DR severity per modified Davis staging:
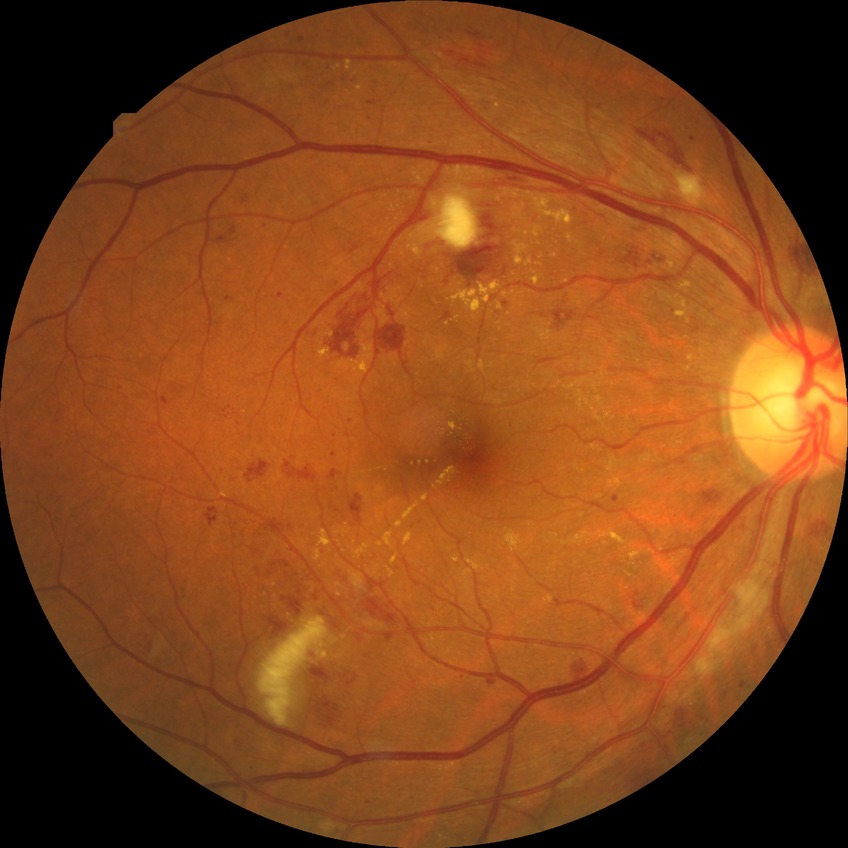
DR class: non-proliferative diabetic retinopathy, diabetic retinopathy (DR): PPDR (pre-proliferative diabetic retinopathy).